Retinal fundus photograph; 2212x1659px — 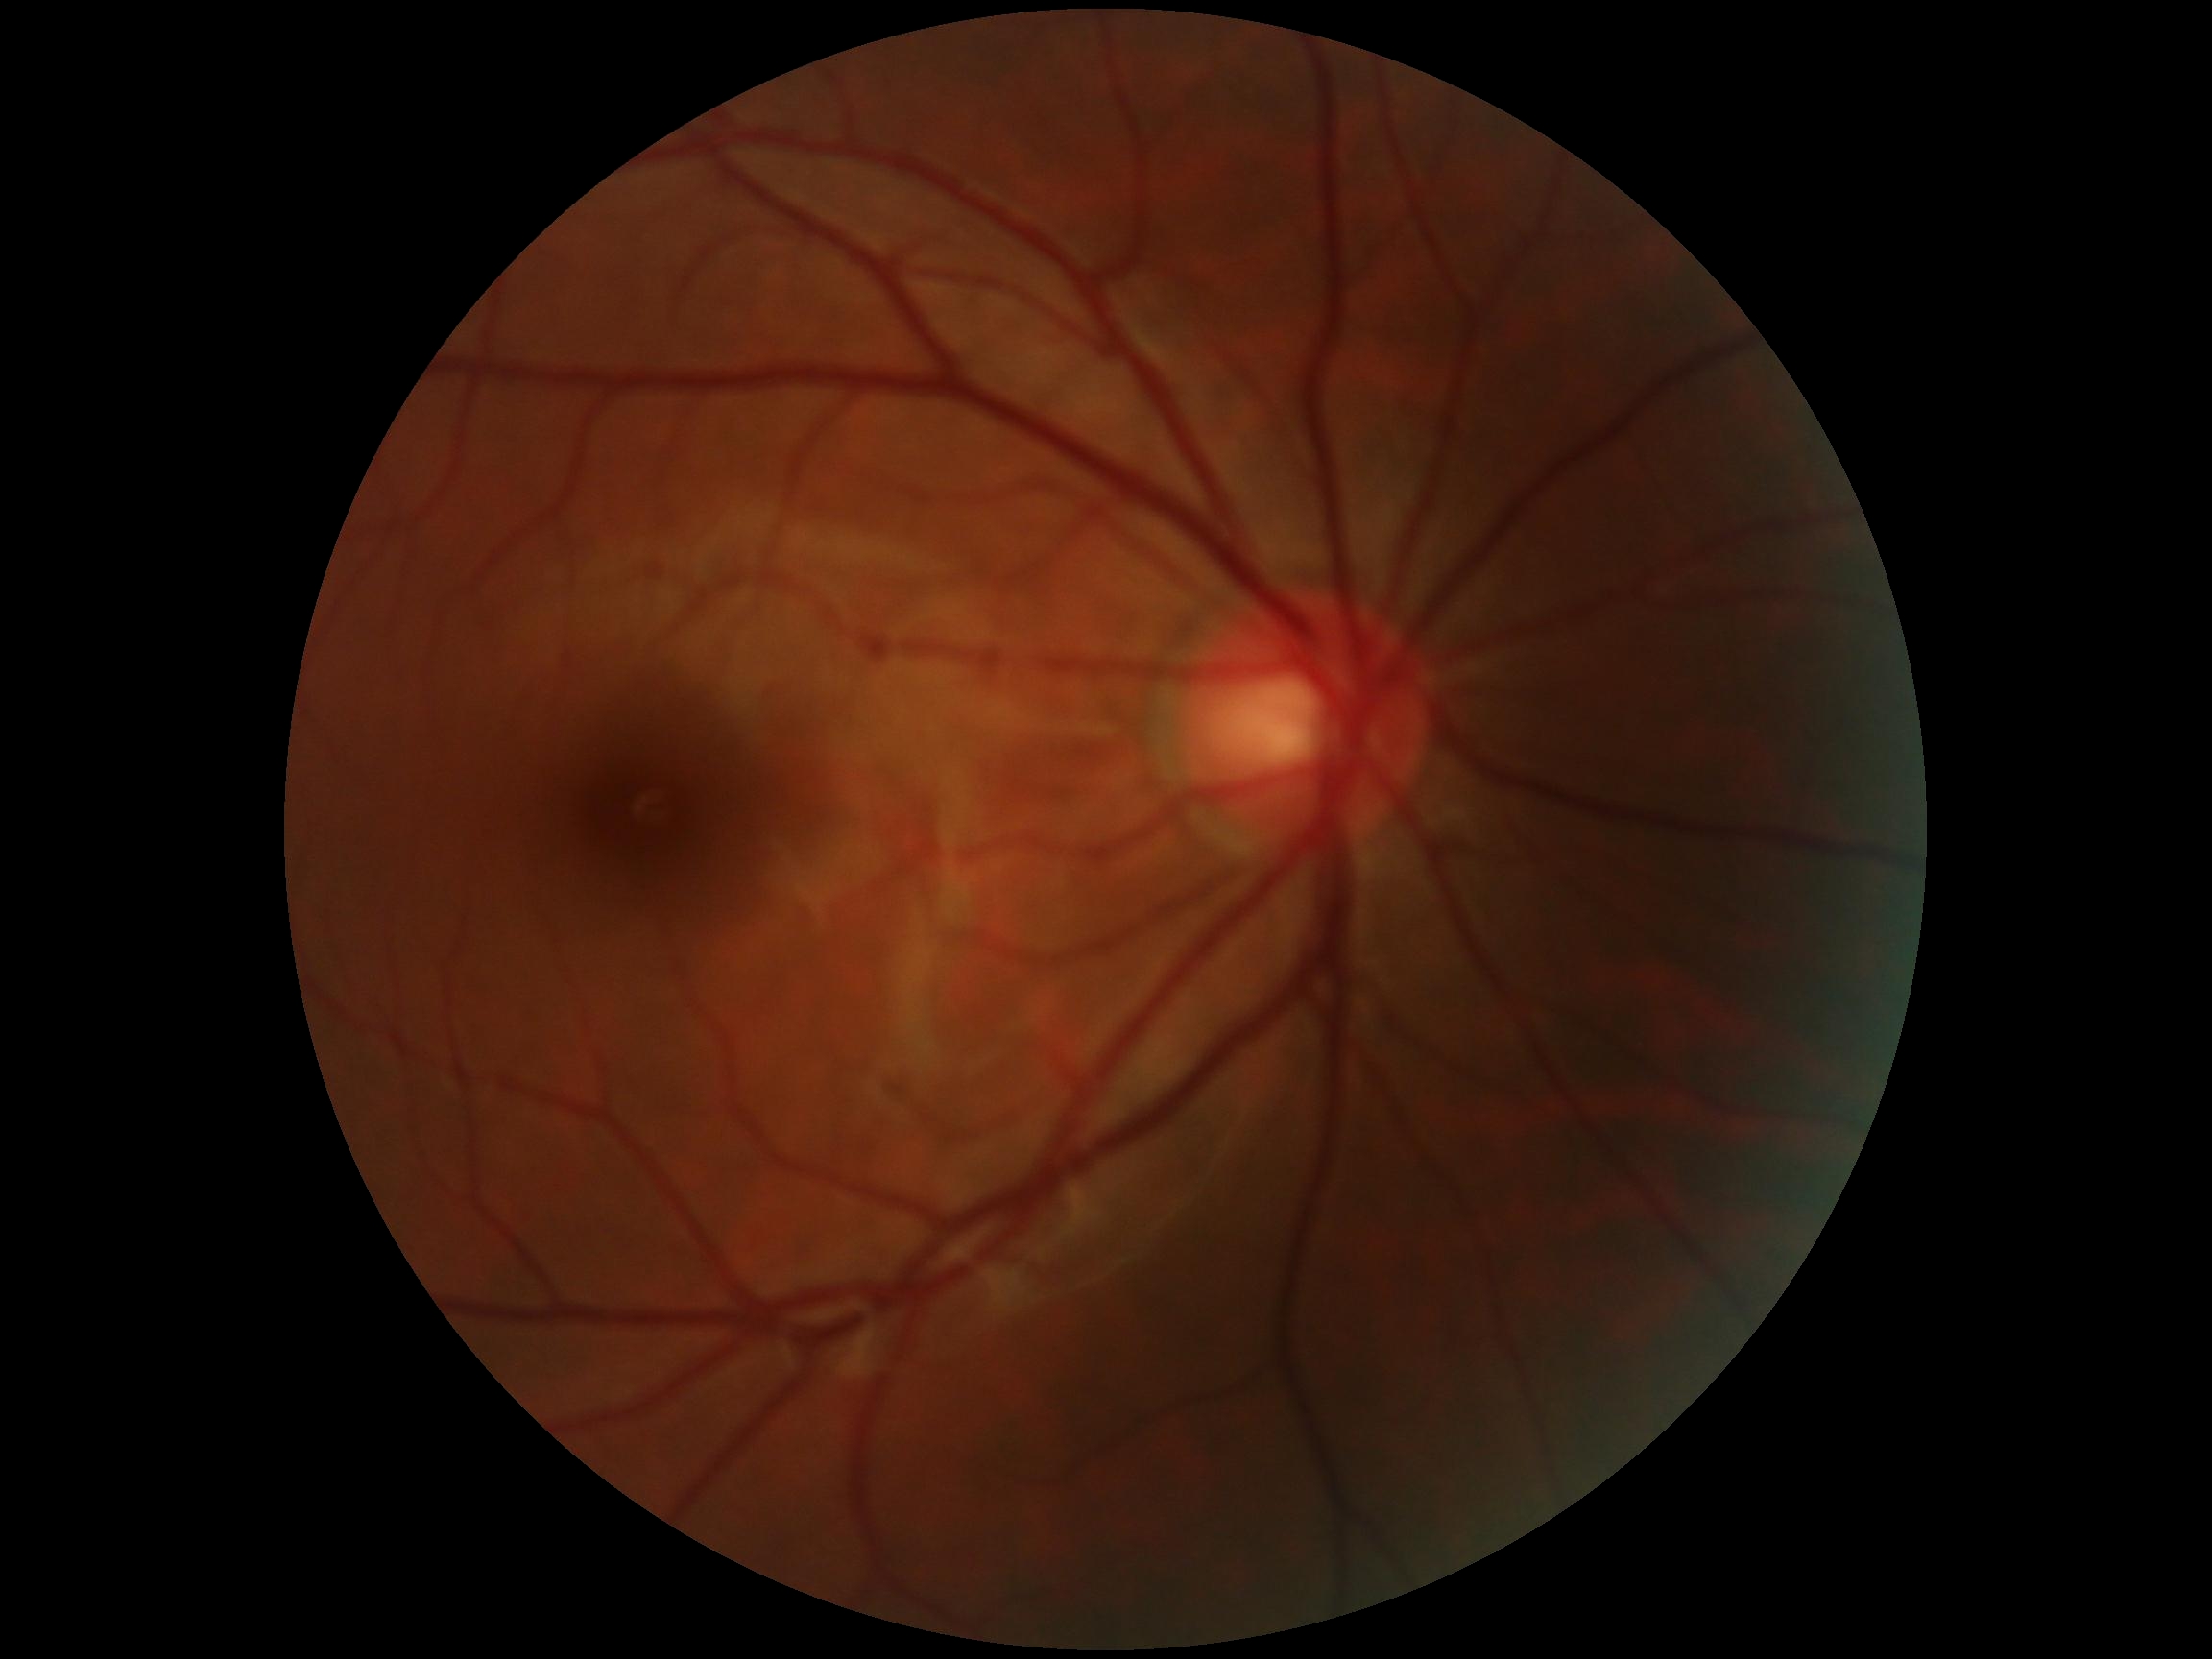 Diabetic retinopathy (DR): grade 0 (no apparent retinopathy).